Image size 848x848, diabetic retinopathy graded by the modified Davis classification
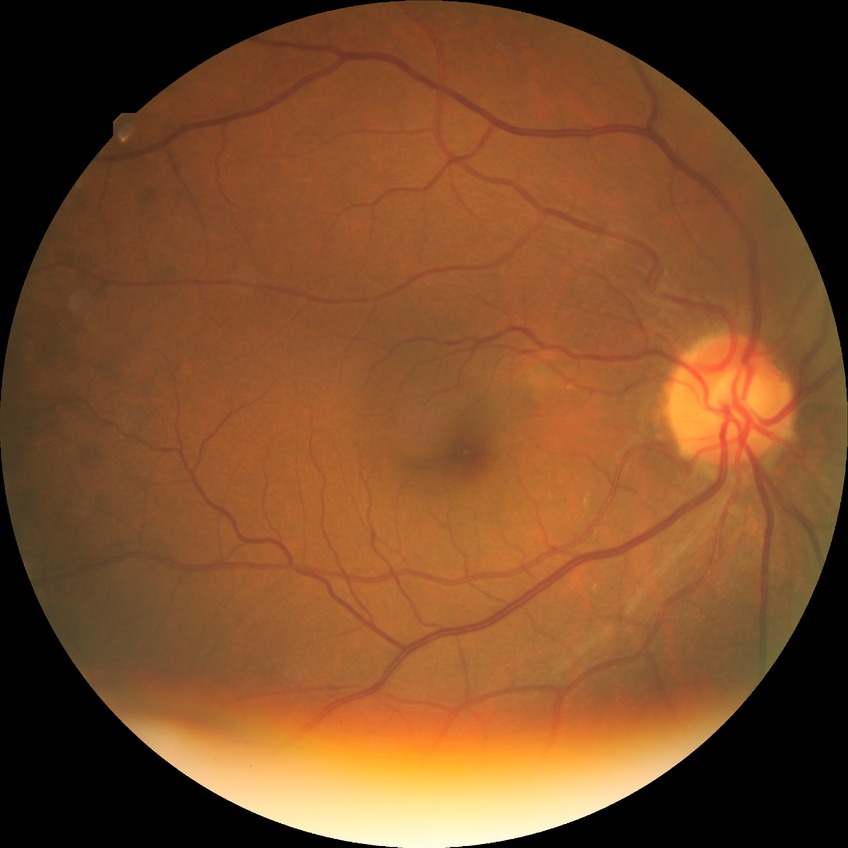

Annotations:
– diabetic retinopathy (DR): NDR (no diabetic retinopathy)